Retinal fundus photograph:
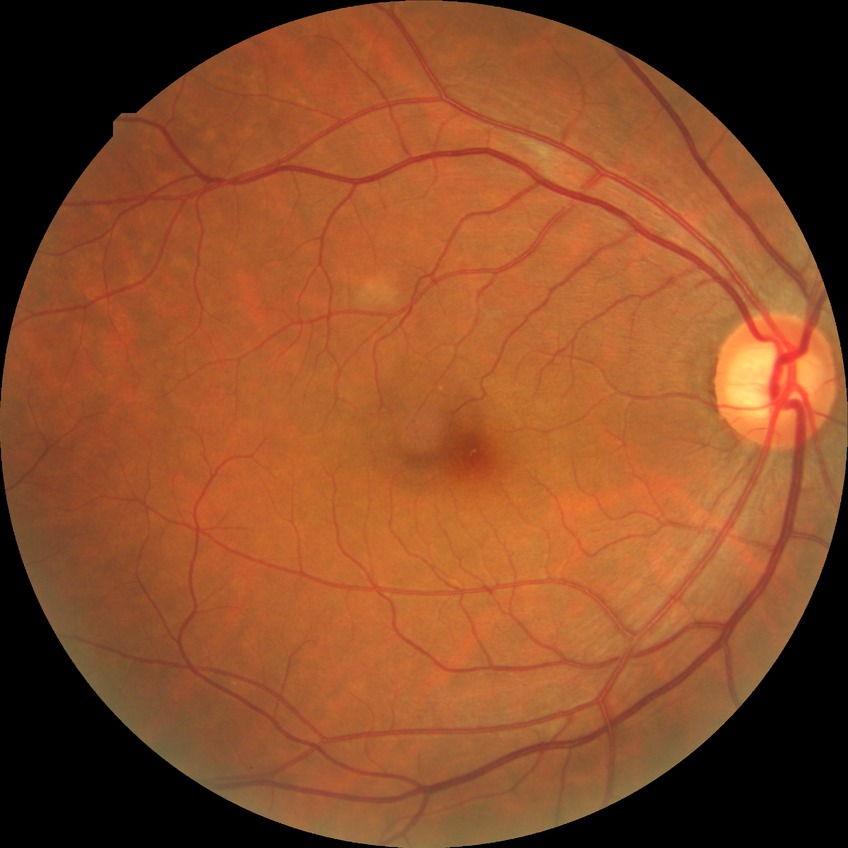
Disease class: non-proliferative diabetic retinopathy. Diabetic retinopathy (DR) is SDR (simple diabetic retinopathy).